Modified Davis grading
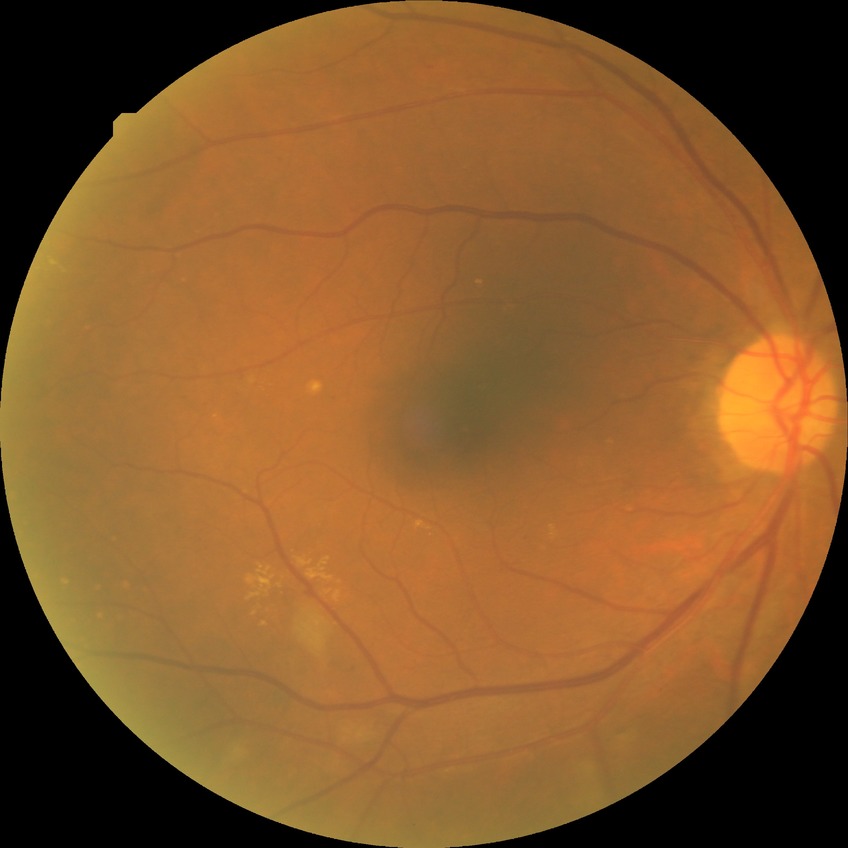 Modified Davis grading: simple diabetic retinopathy.